Nonmydriatic fundus photograph · 848x848:
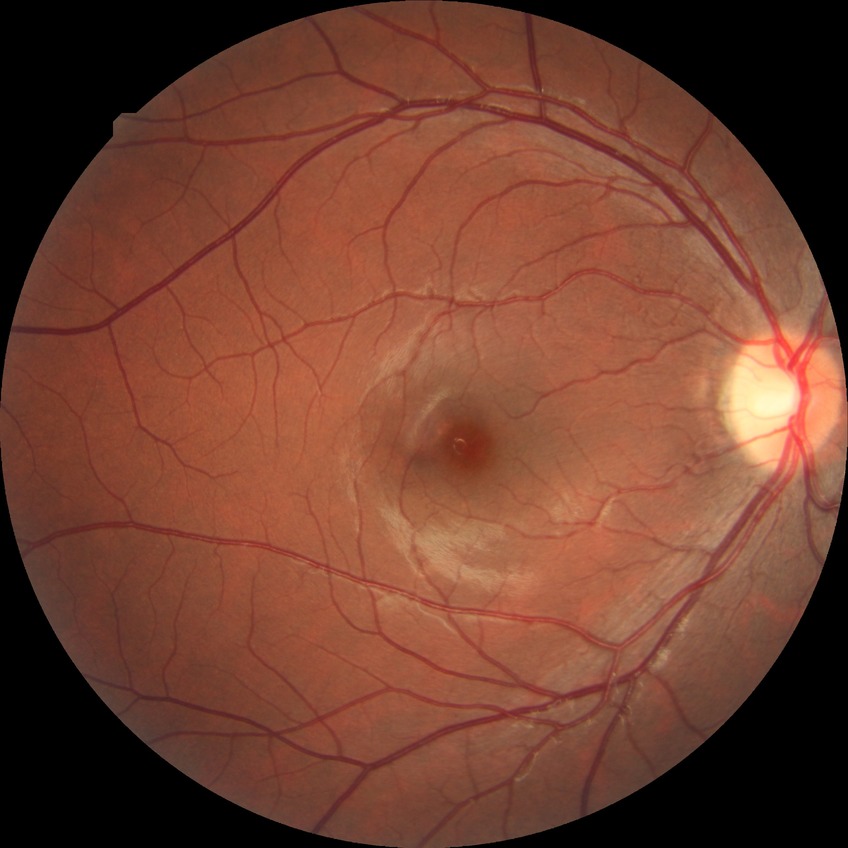

Diabetic retinopathy severity is no diabetic retinopathy.